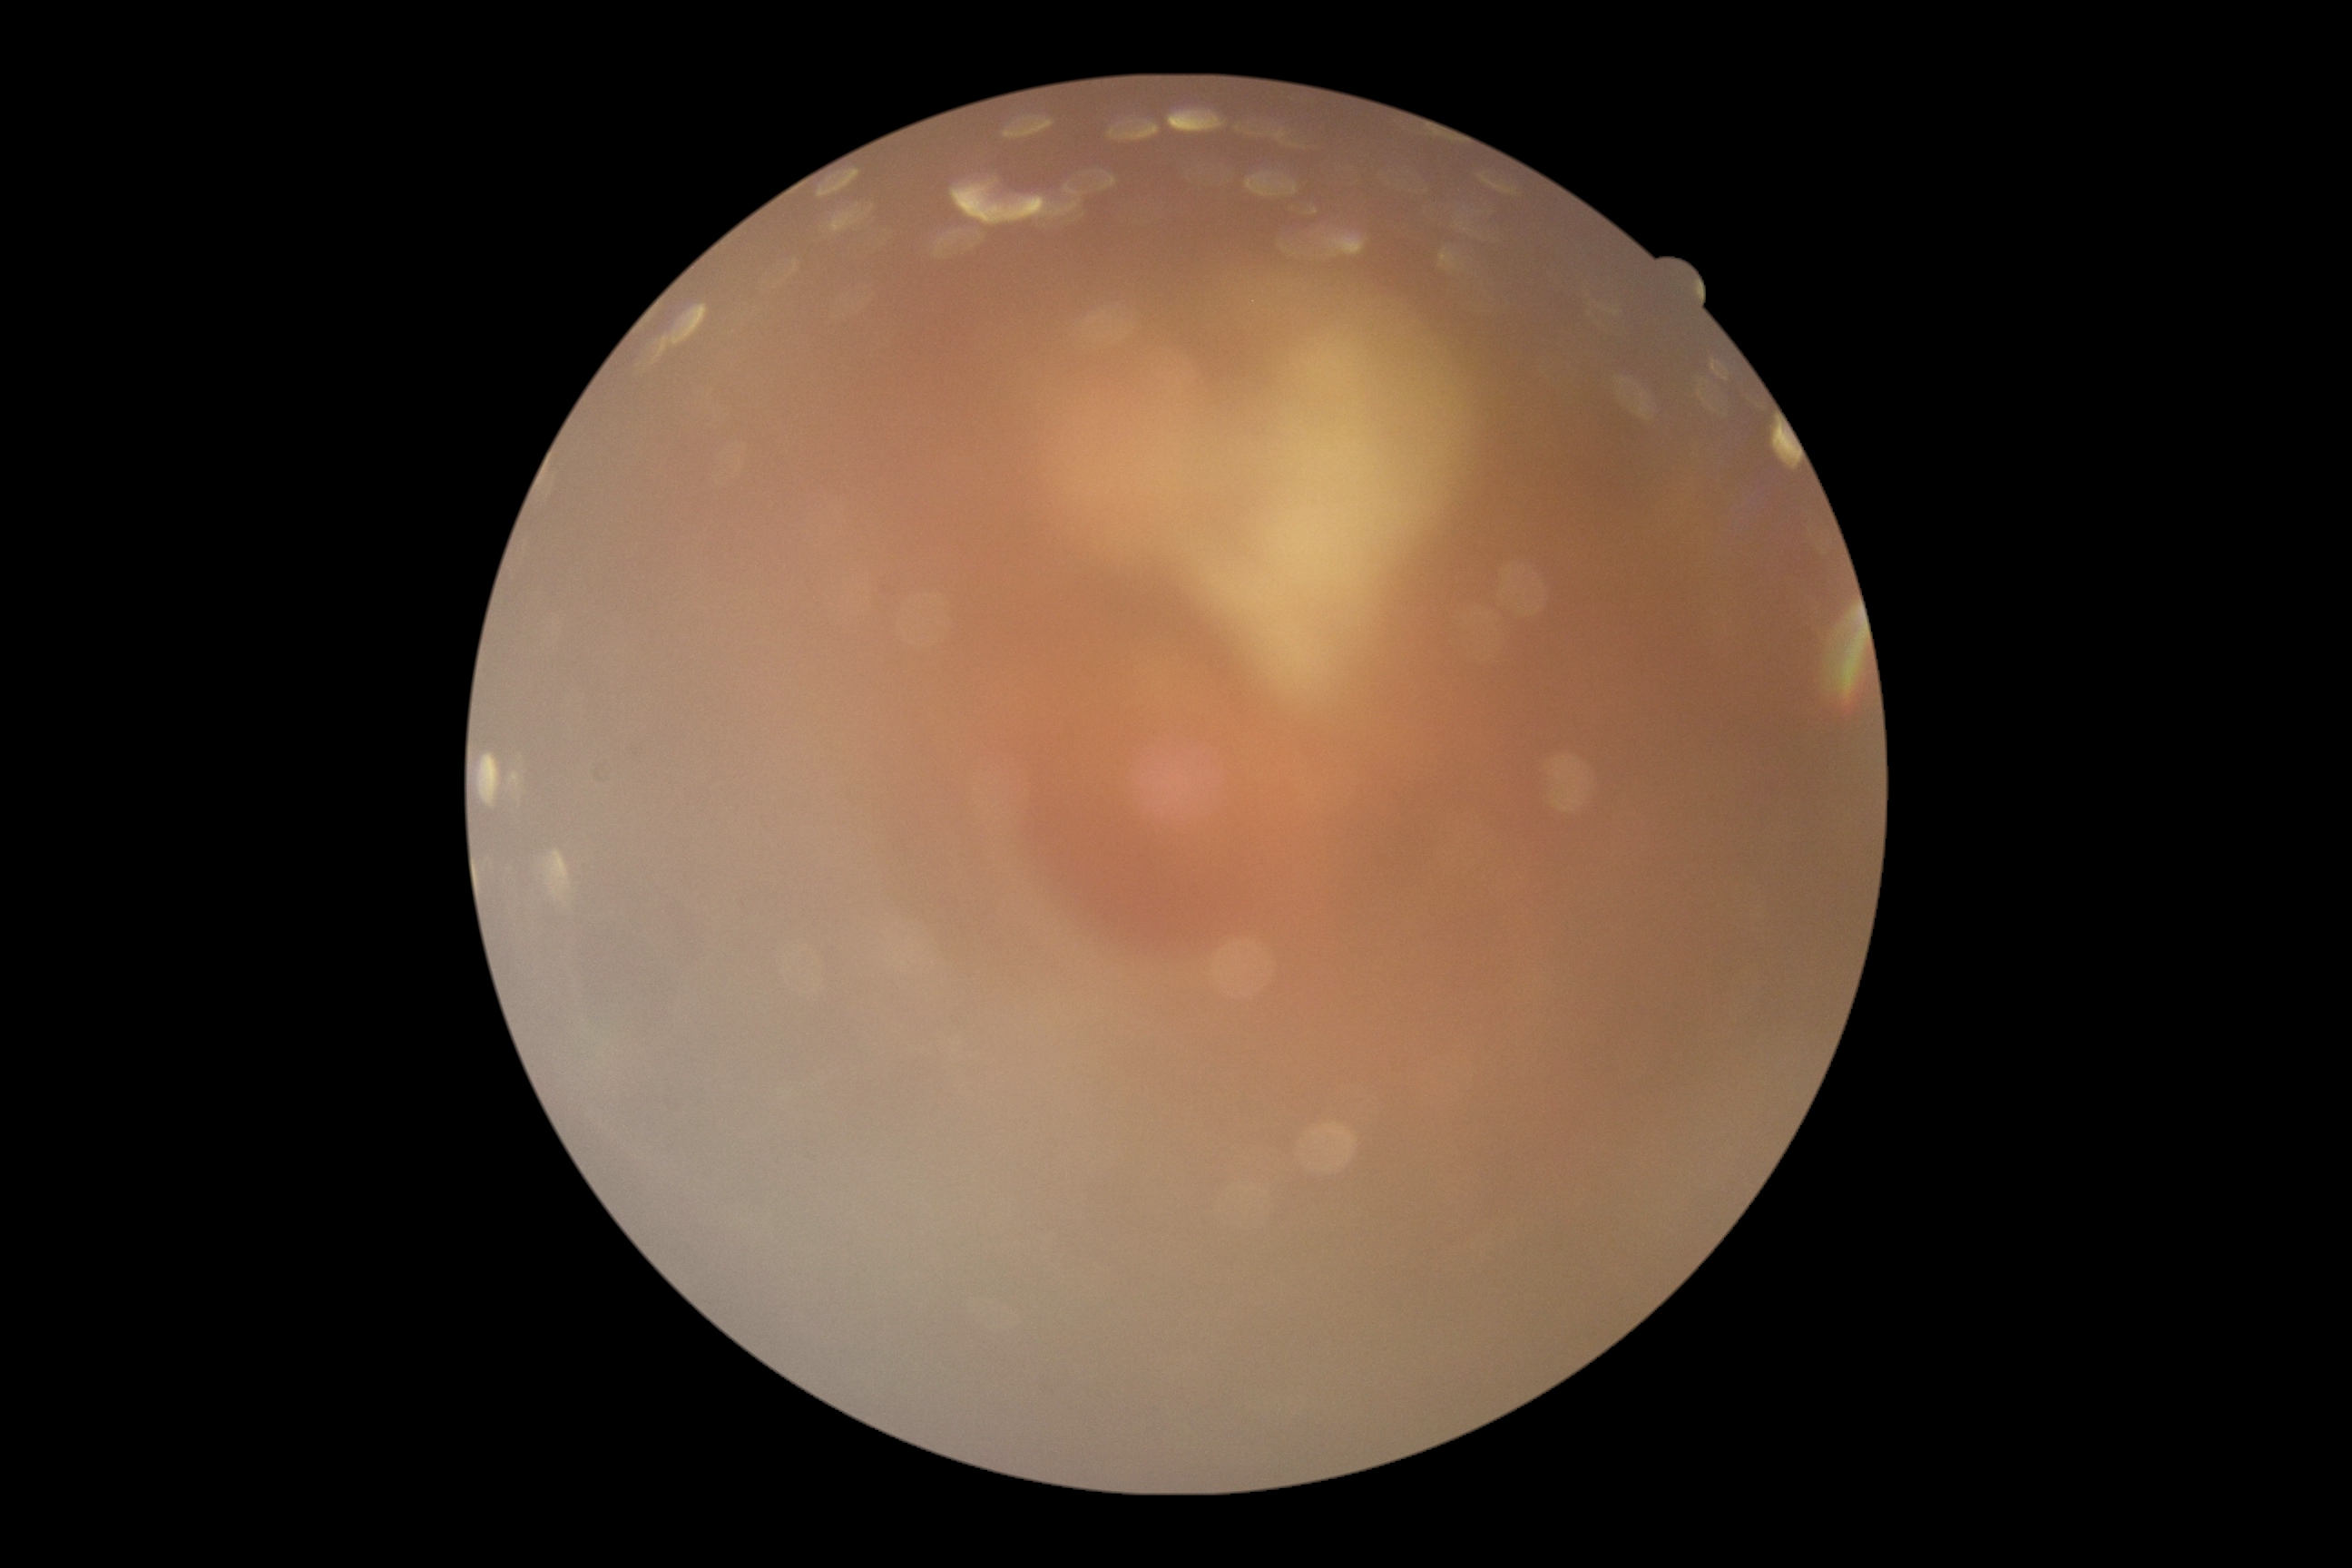 Diabetic retinopathy (DR) is ungradable due to poor image quality.